848x848px, color fundus photograph, acquired with a NIDEK AFC-230, 45° FOV, nonmydriatic fundus photograph
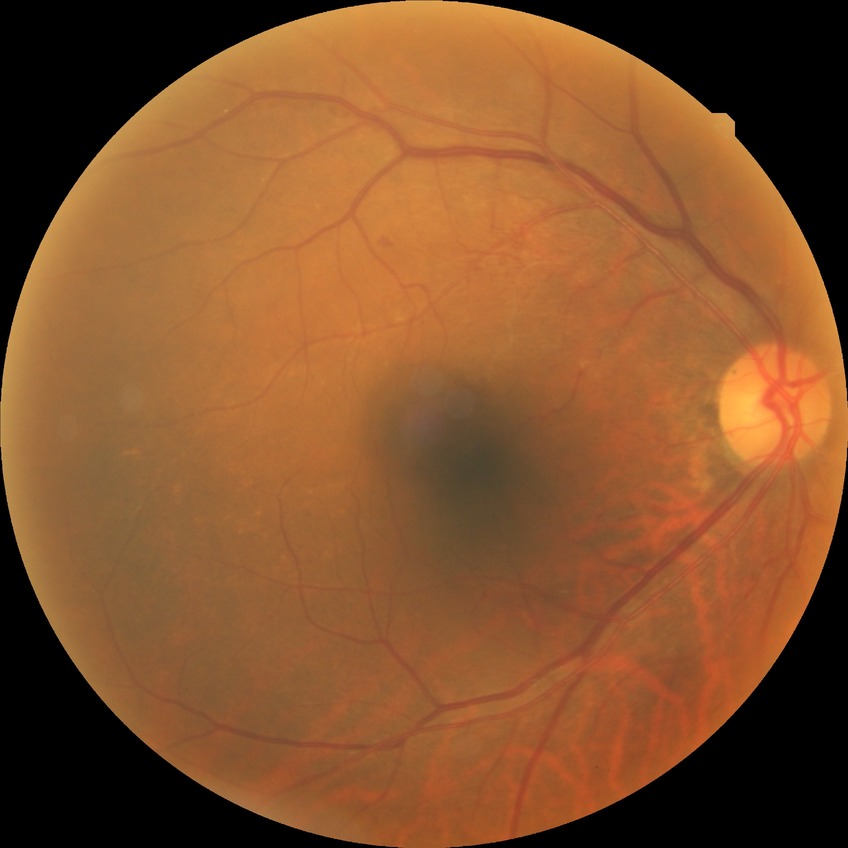 Disease class: non-proliferative diabetic retinopathy. Davis grading is simple diabetic retinopathy.